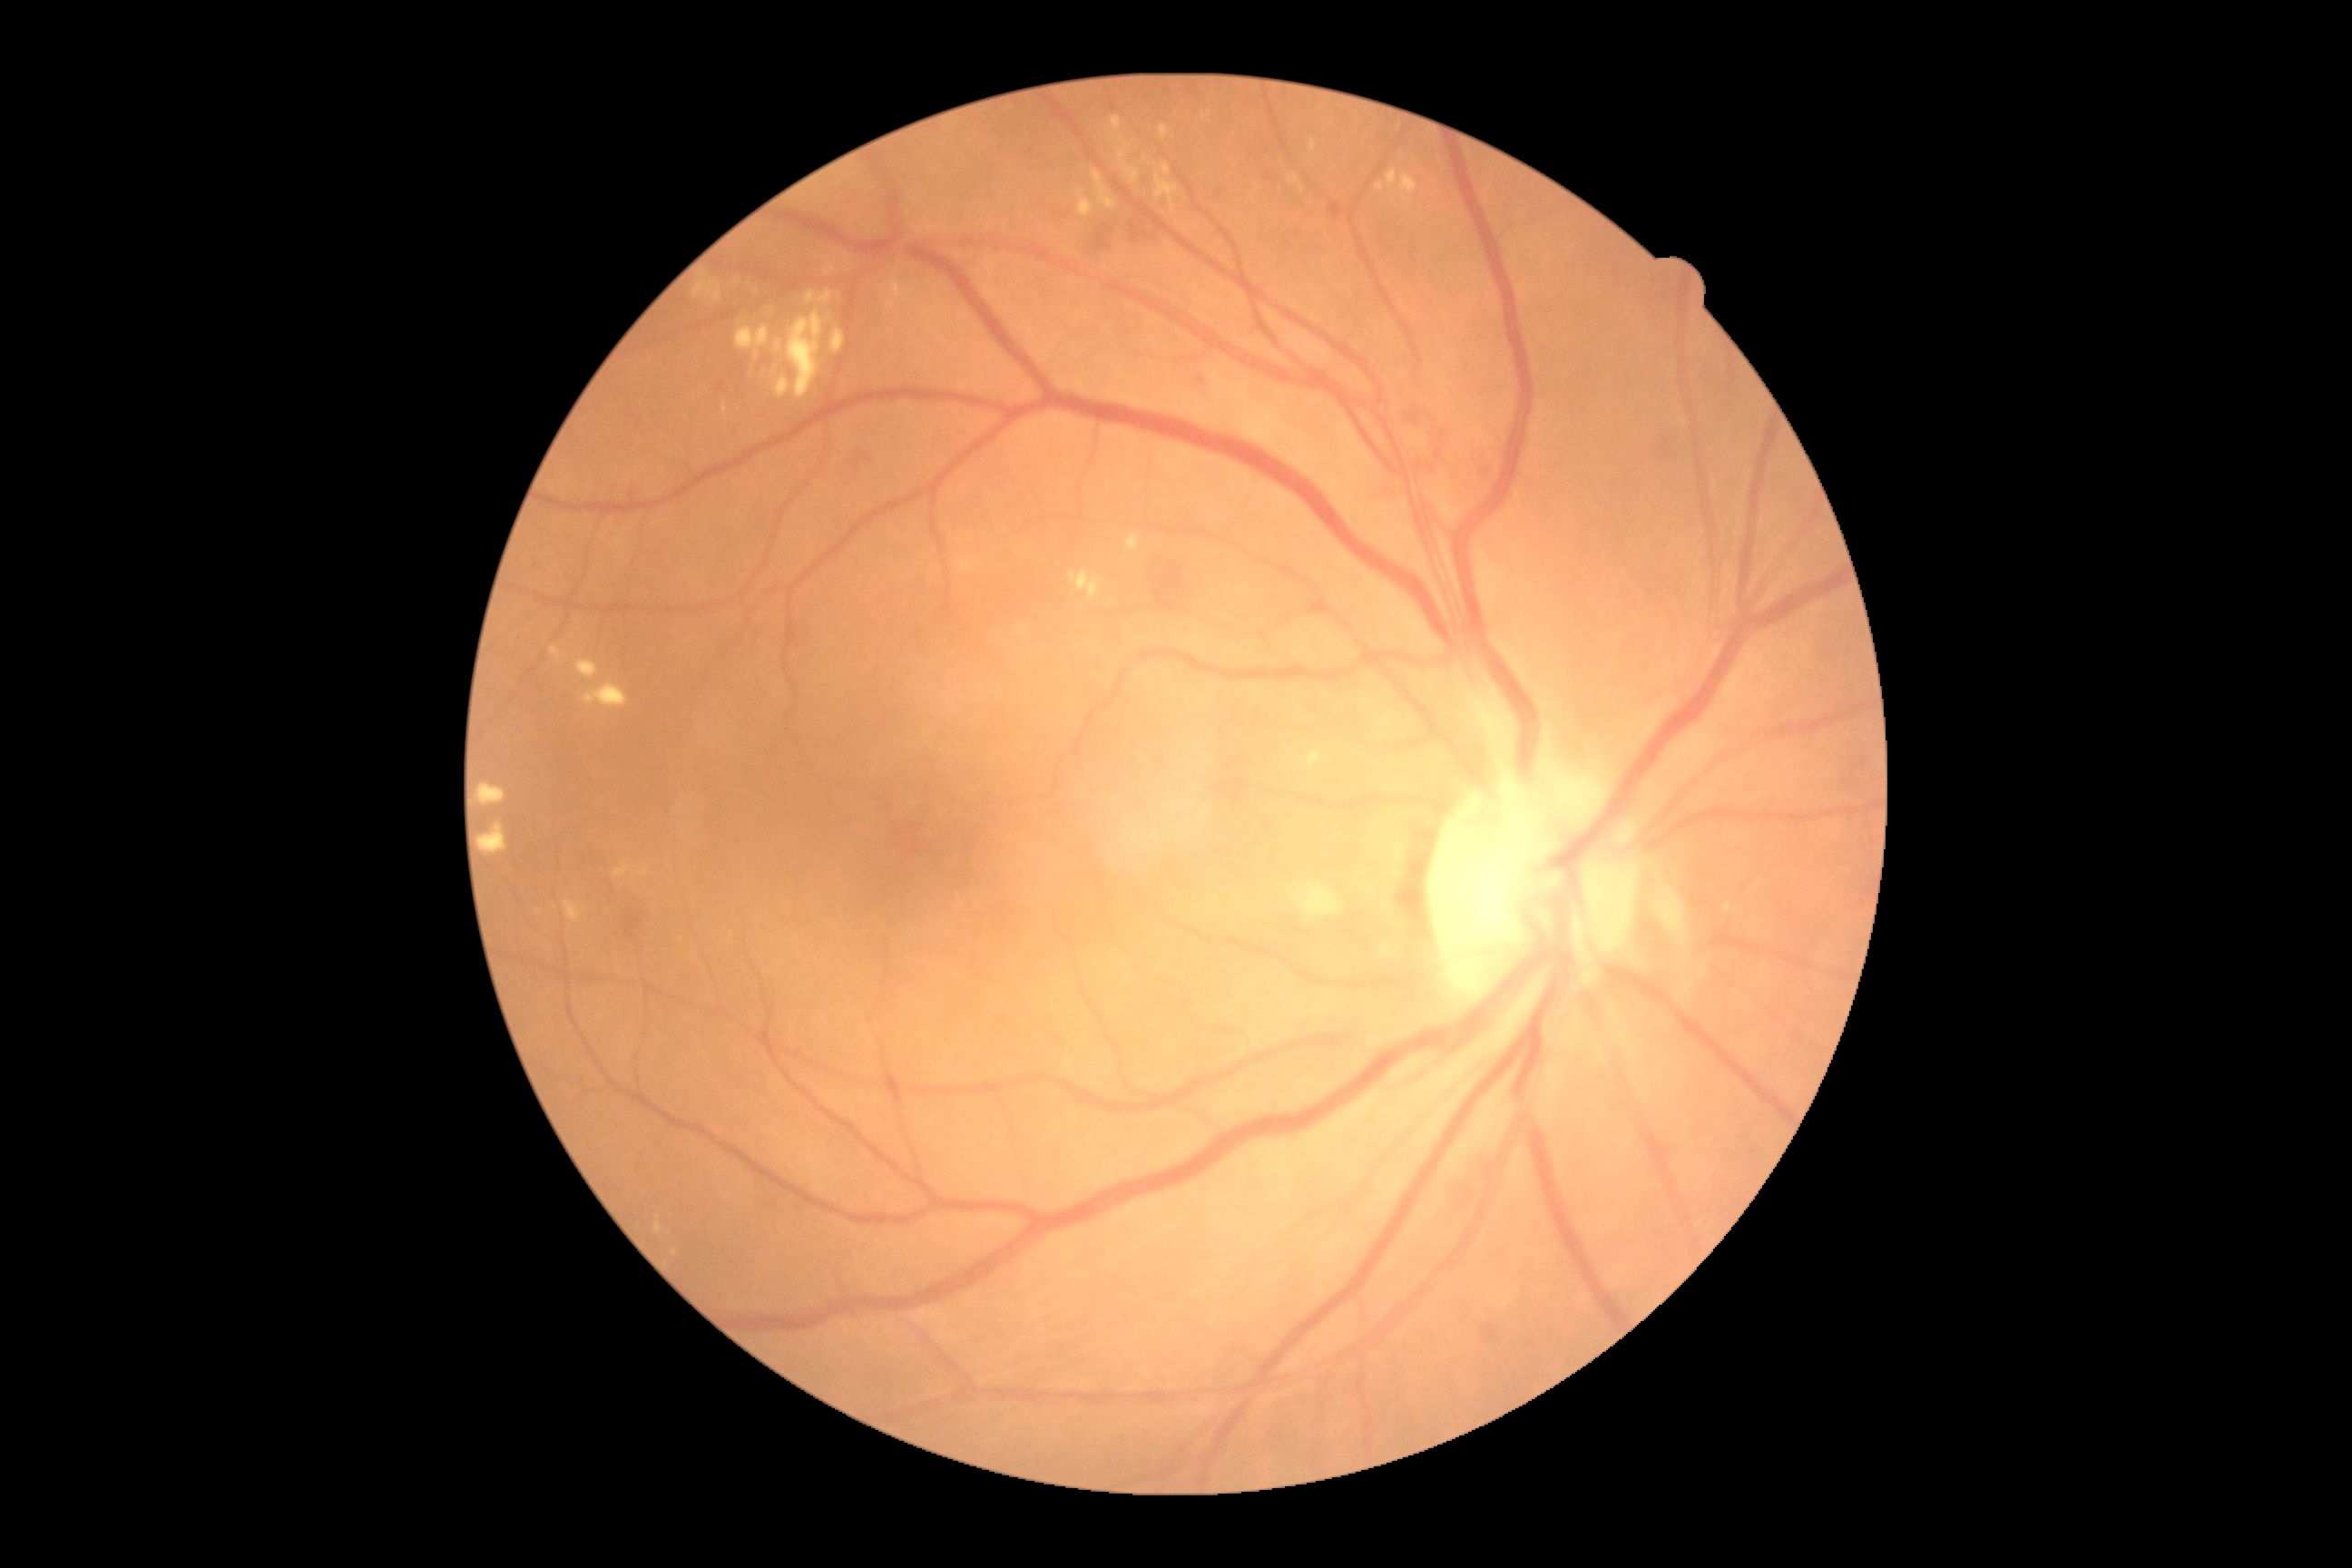 DR stage: 2.